45-degree field of view — 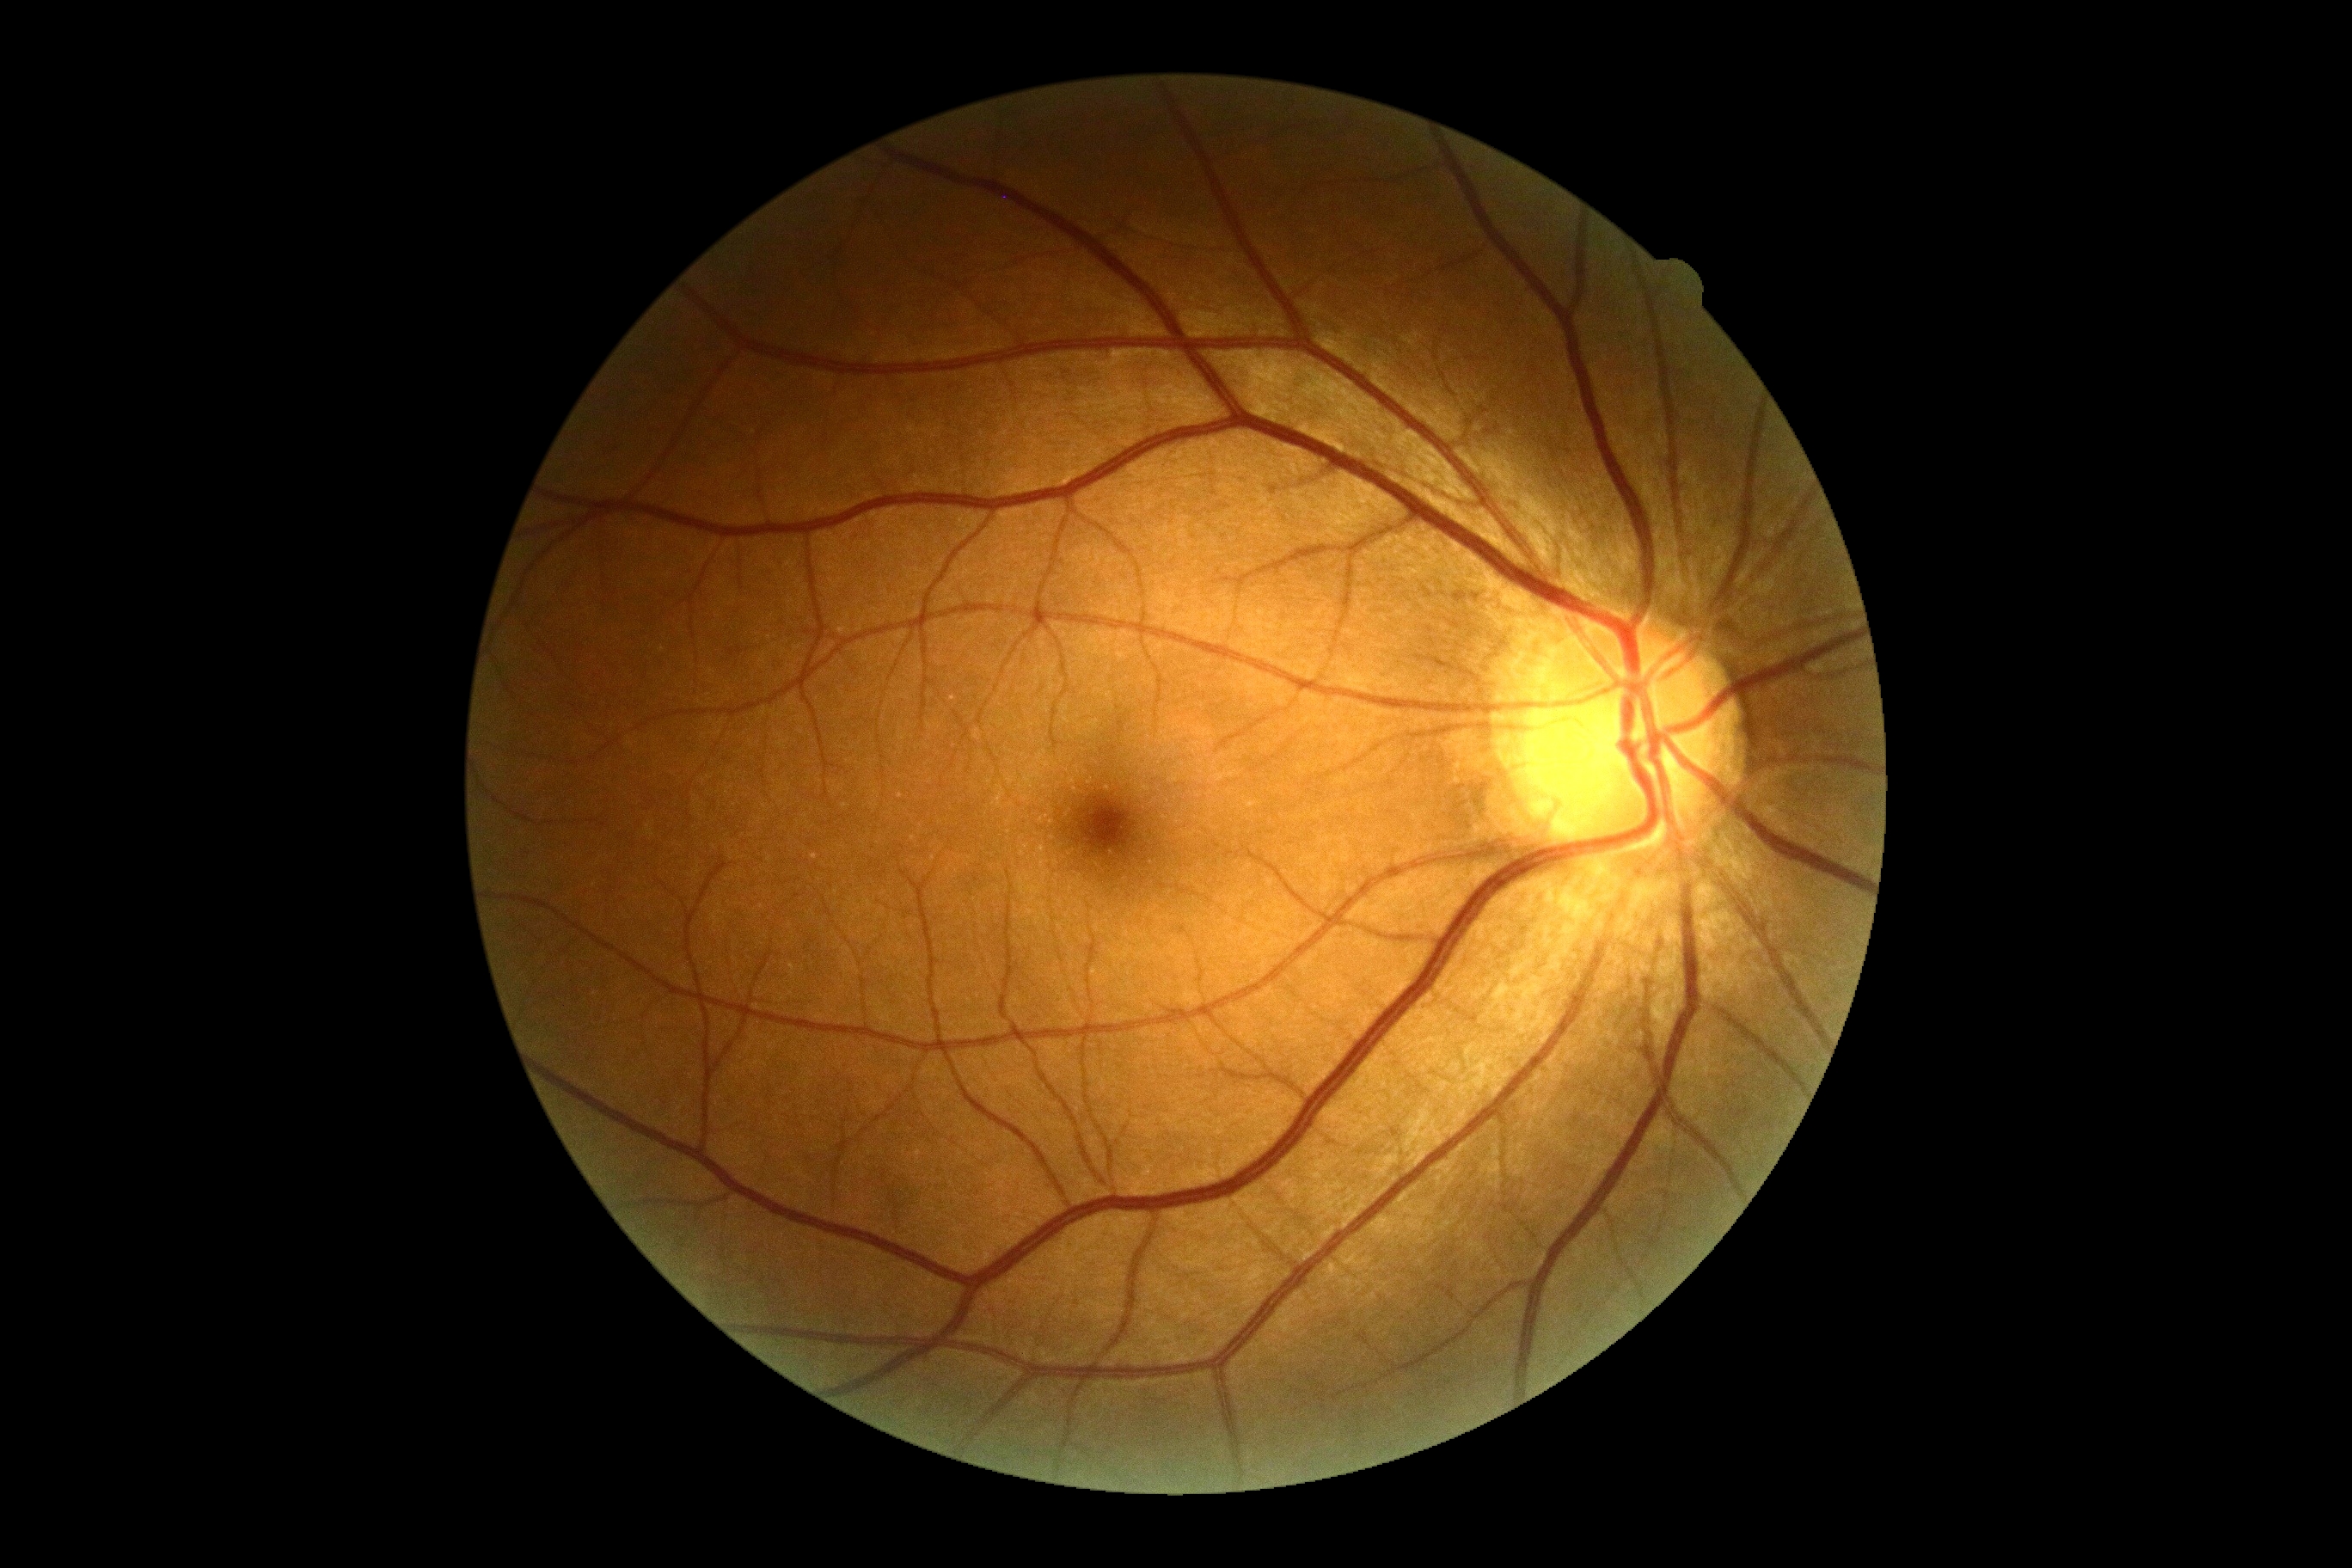
diabetic retinopathy (DR): no apparent diabetic retinopathy (grade 0) — no visible signs of diabetic retinopathy
DR impression: no DR findings